FOV: 45 degrees. Color fundus photograph. Image size 2048x1536: 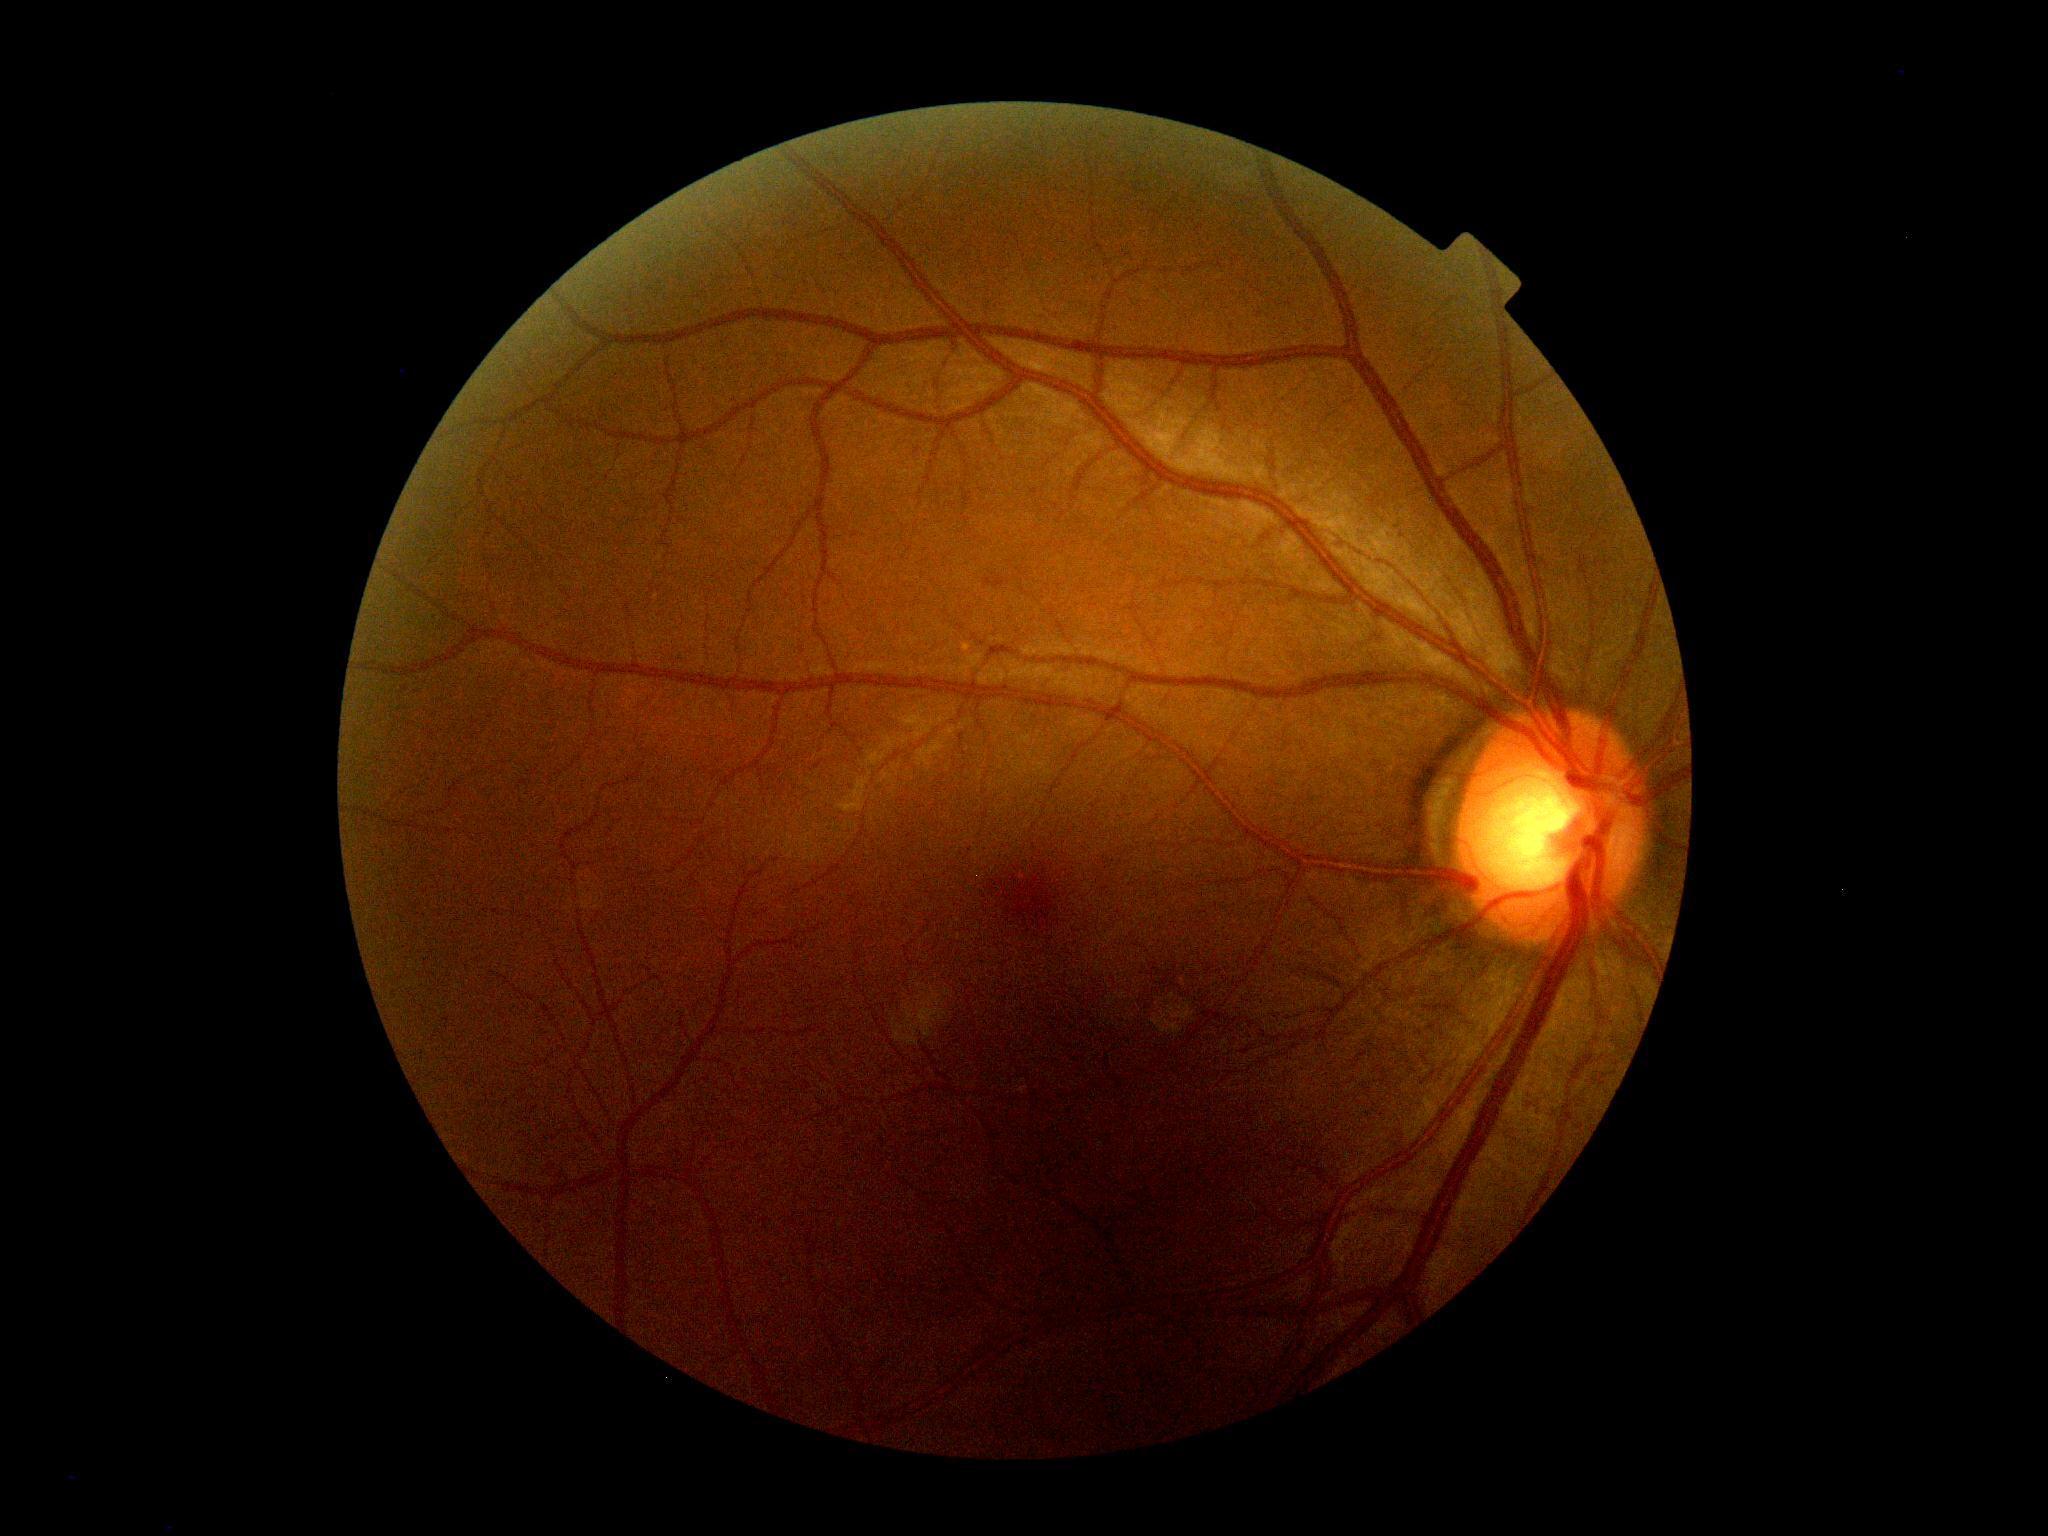 DR impression = negative for DR | DR severity = 0.